50° field of view · dilated-pupil acquisition · 2361 x 1568 pixels
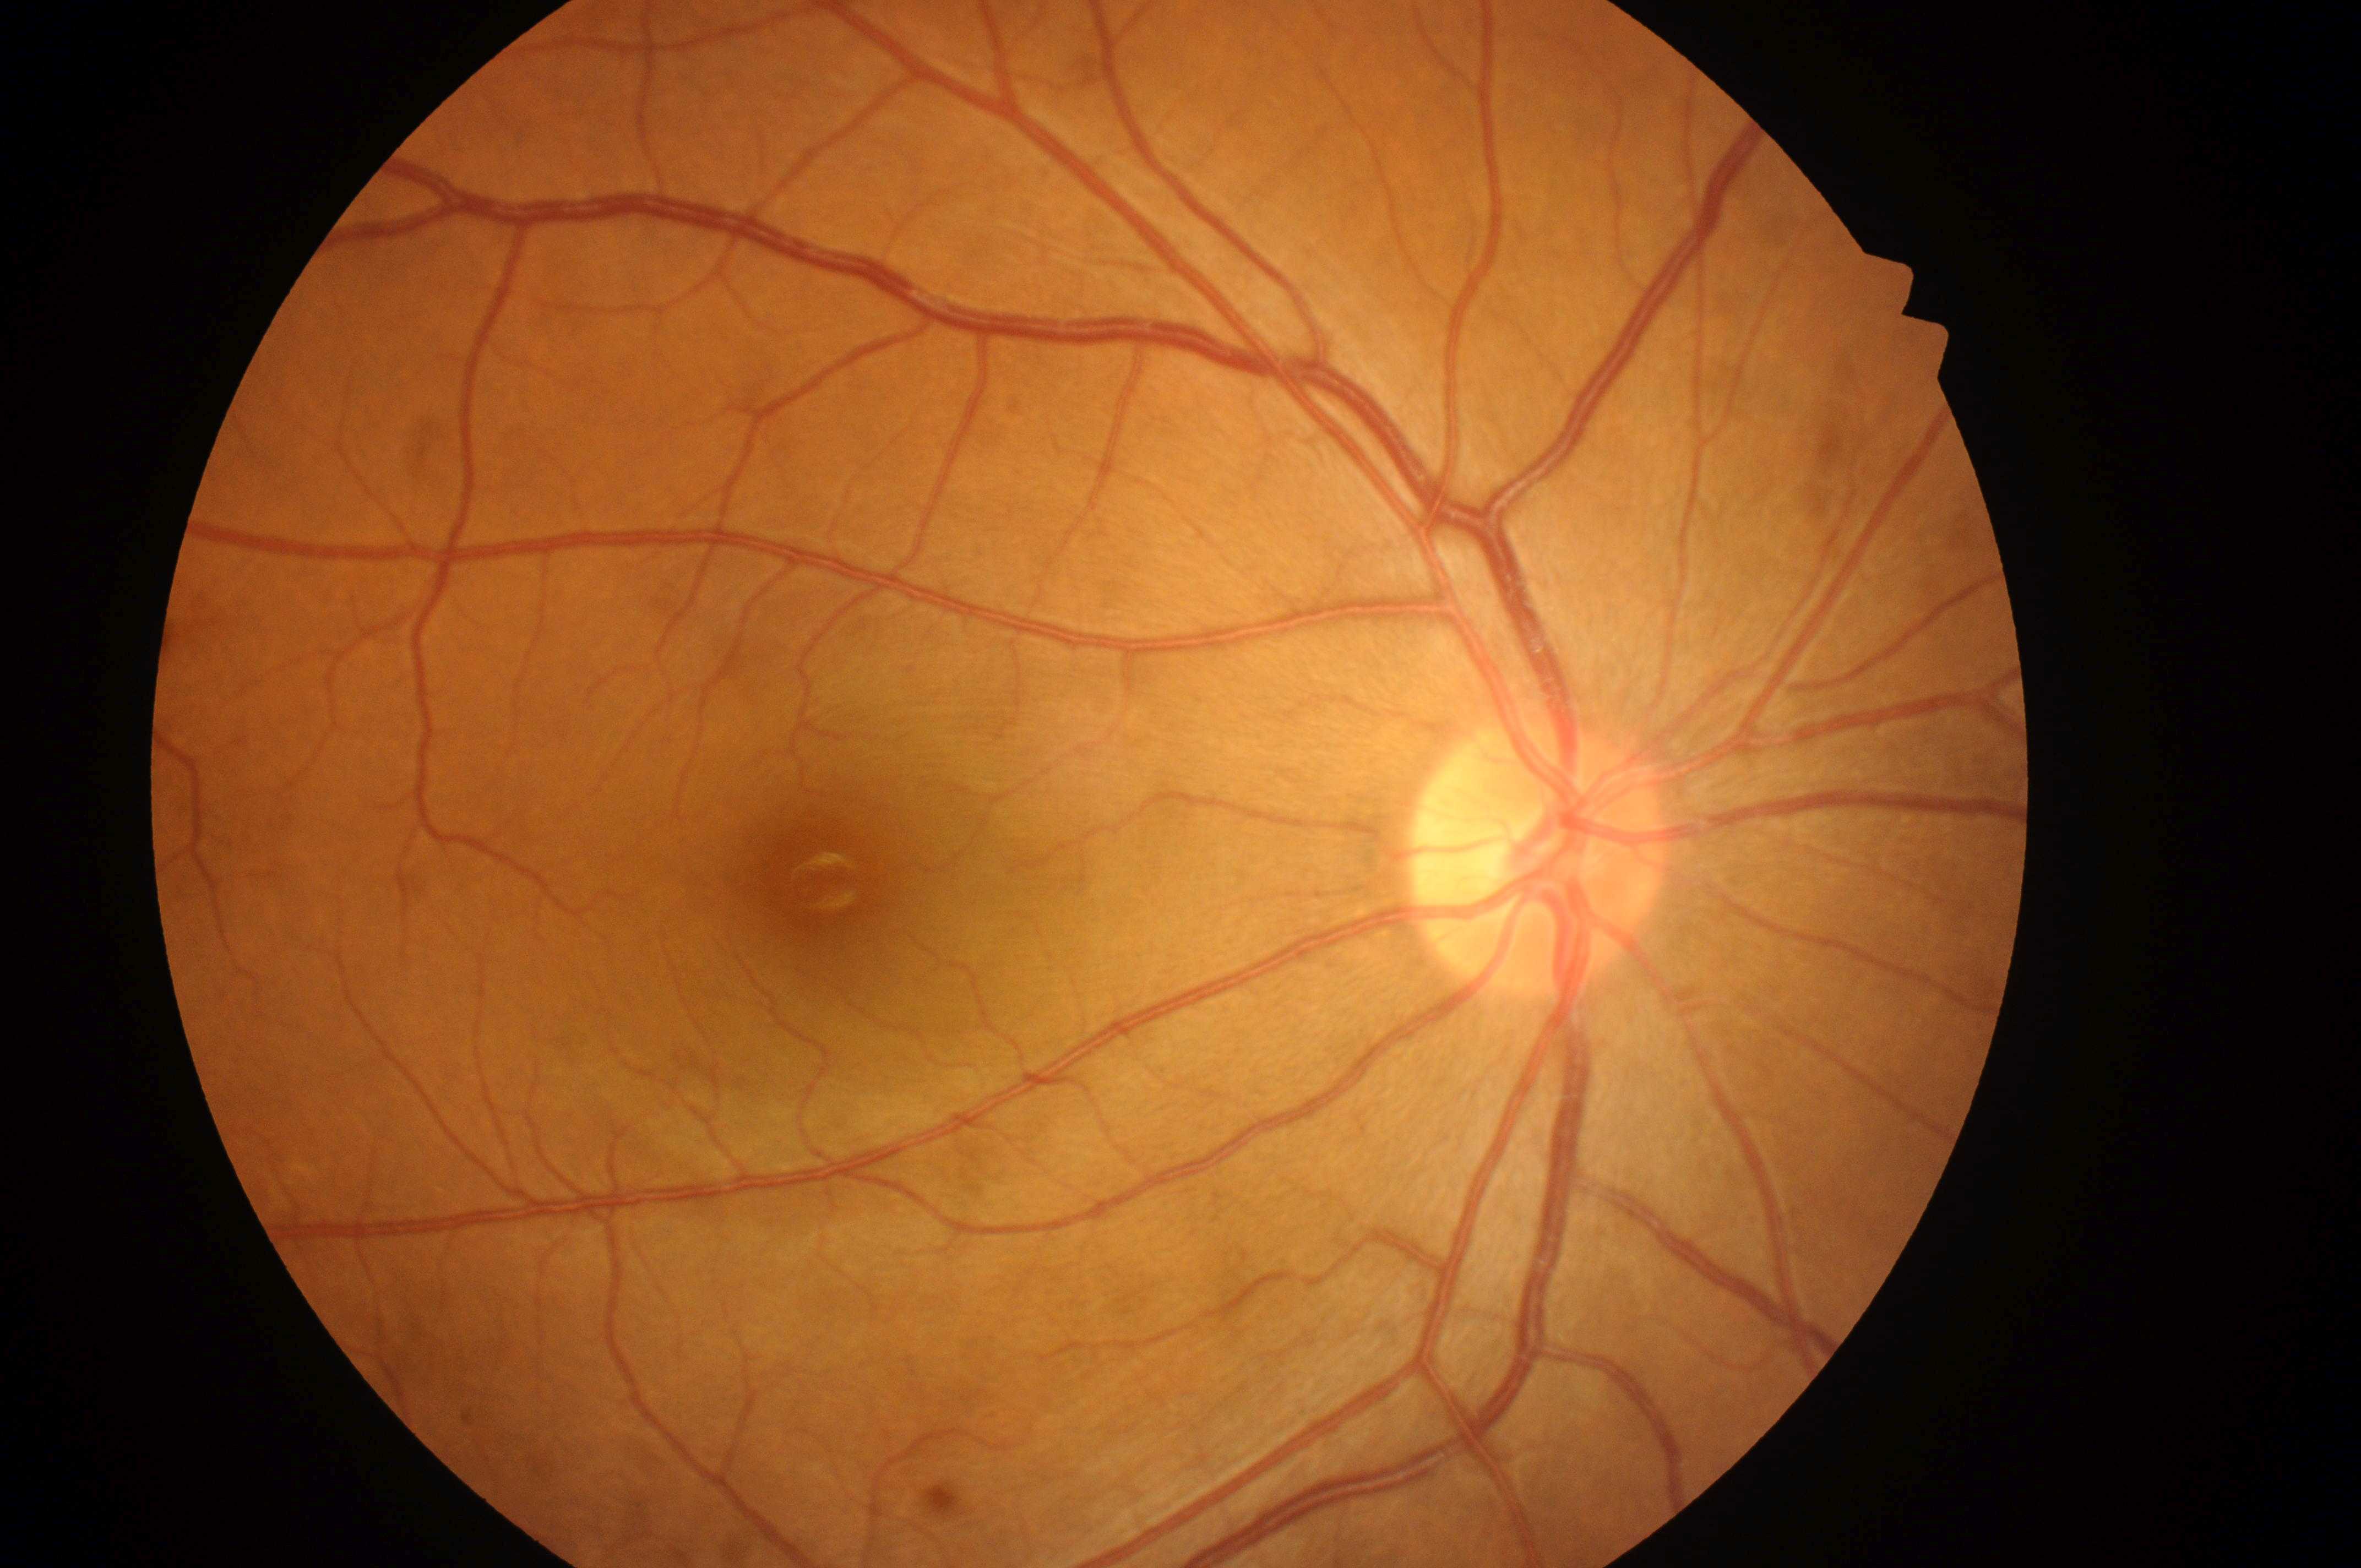
The optic disc is at 1532, 864.
Foveal center: 821, 880.
Diabetic retinopathy (DR): grade 0 (no apparent retinopathy).
This is the right eye.
Diabetic macular edema (DME) is no risk (grade 0).